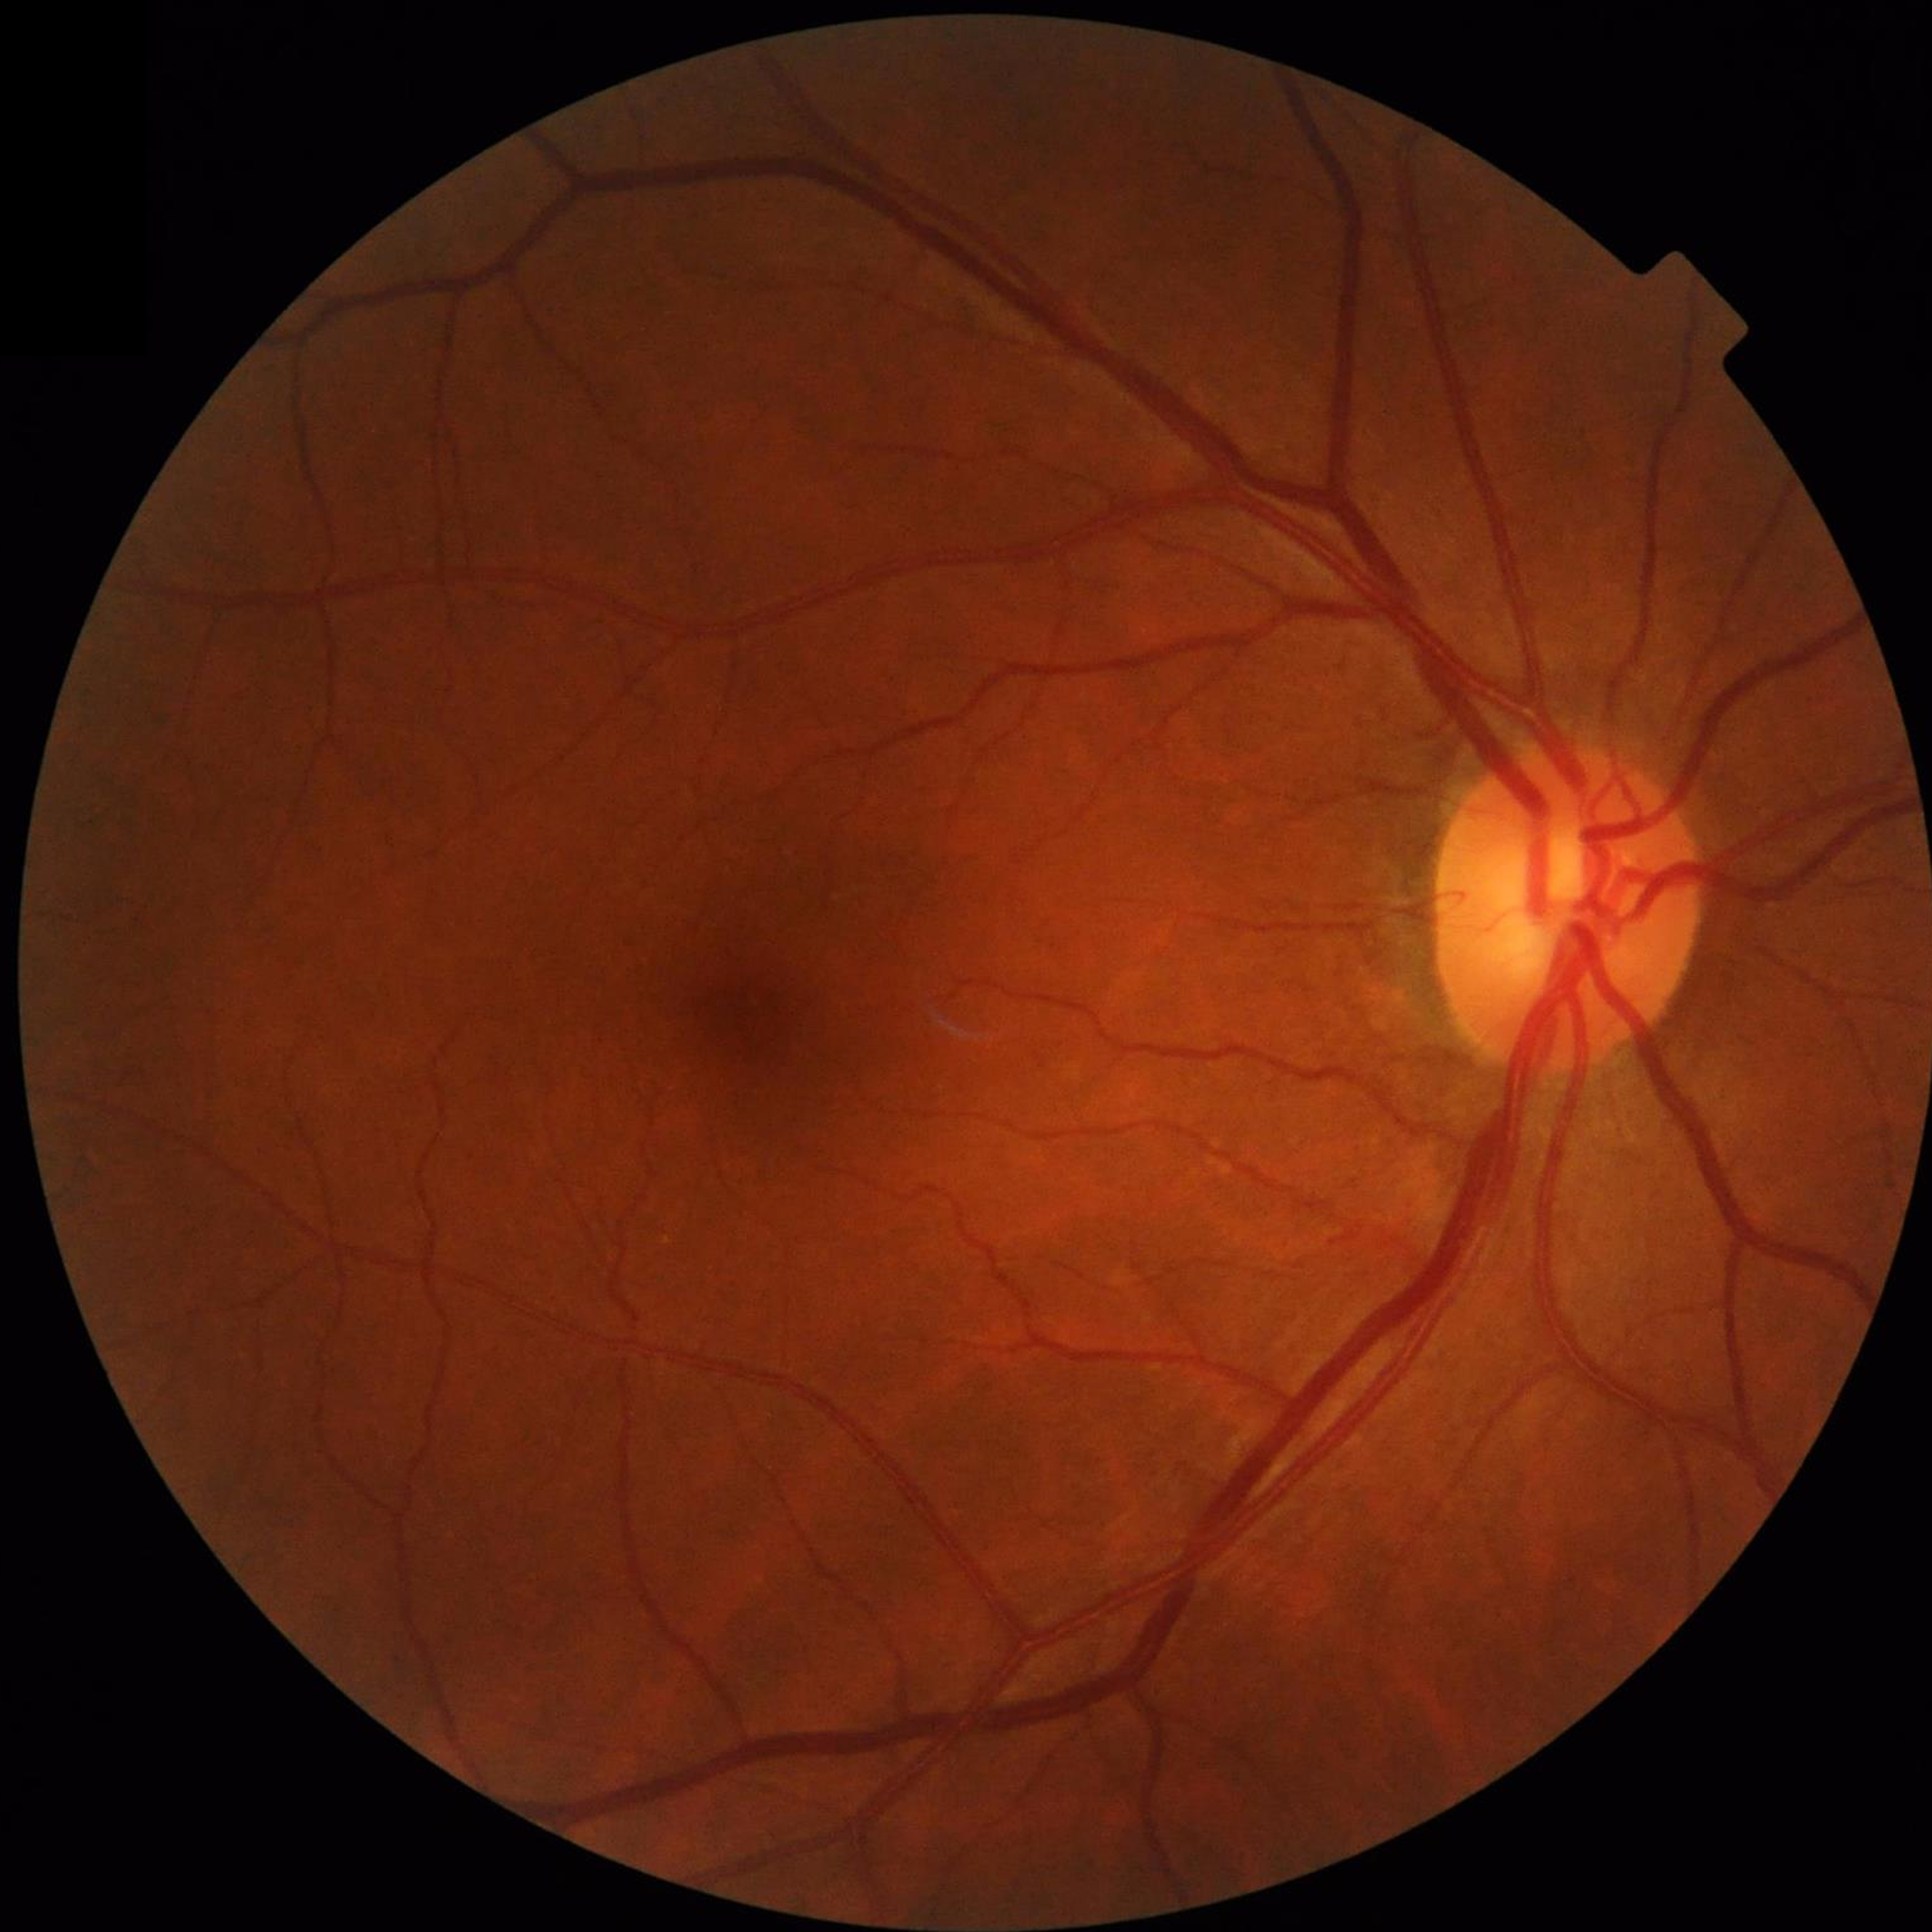
From a control without AMD, diabetic retinopathy, or glaucoma.